Captured on a Nidek AFC-330 fundus camera — 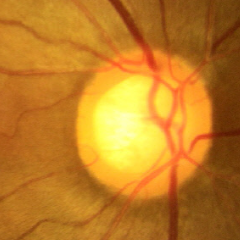 Impression = no glaucoma.